Davis DR grading.
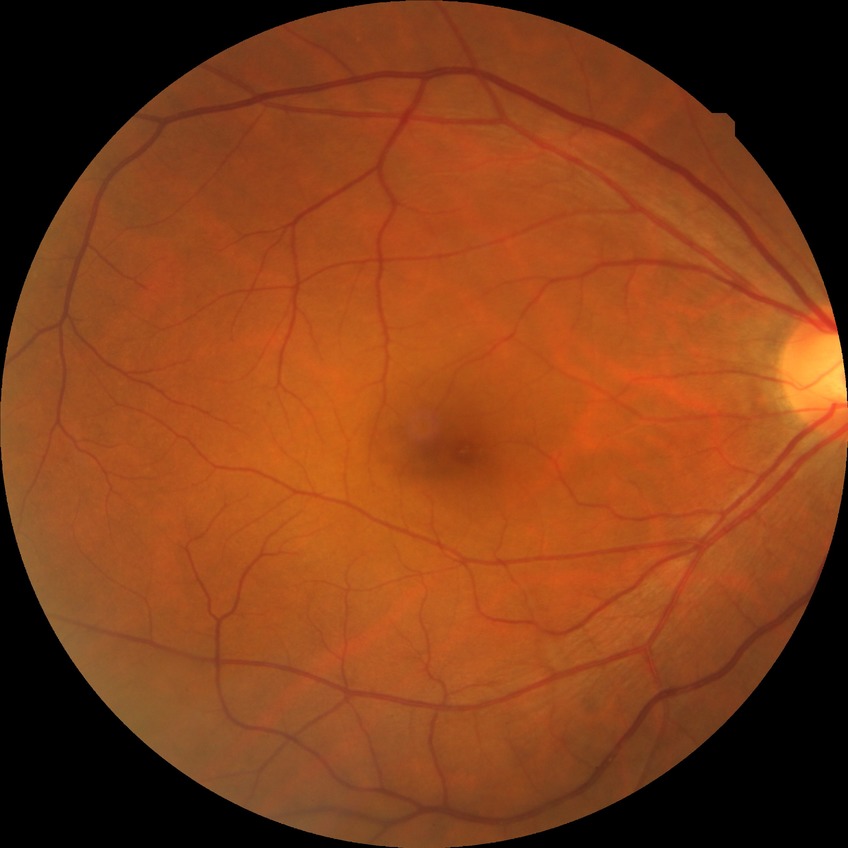 retinopathy grade = no diabetic retinopathy.